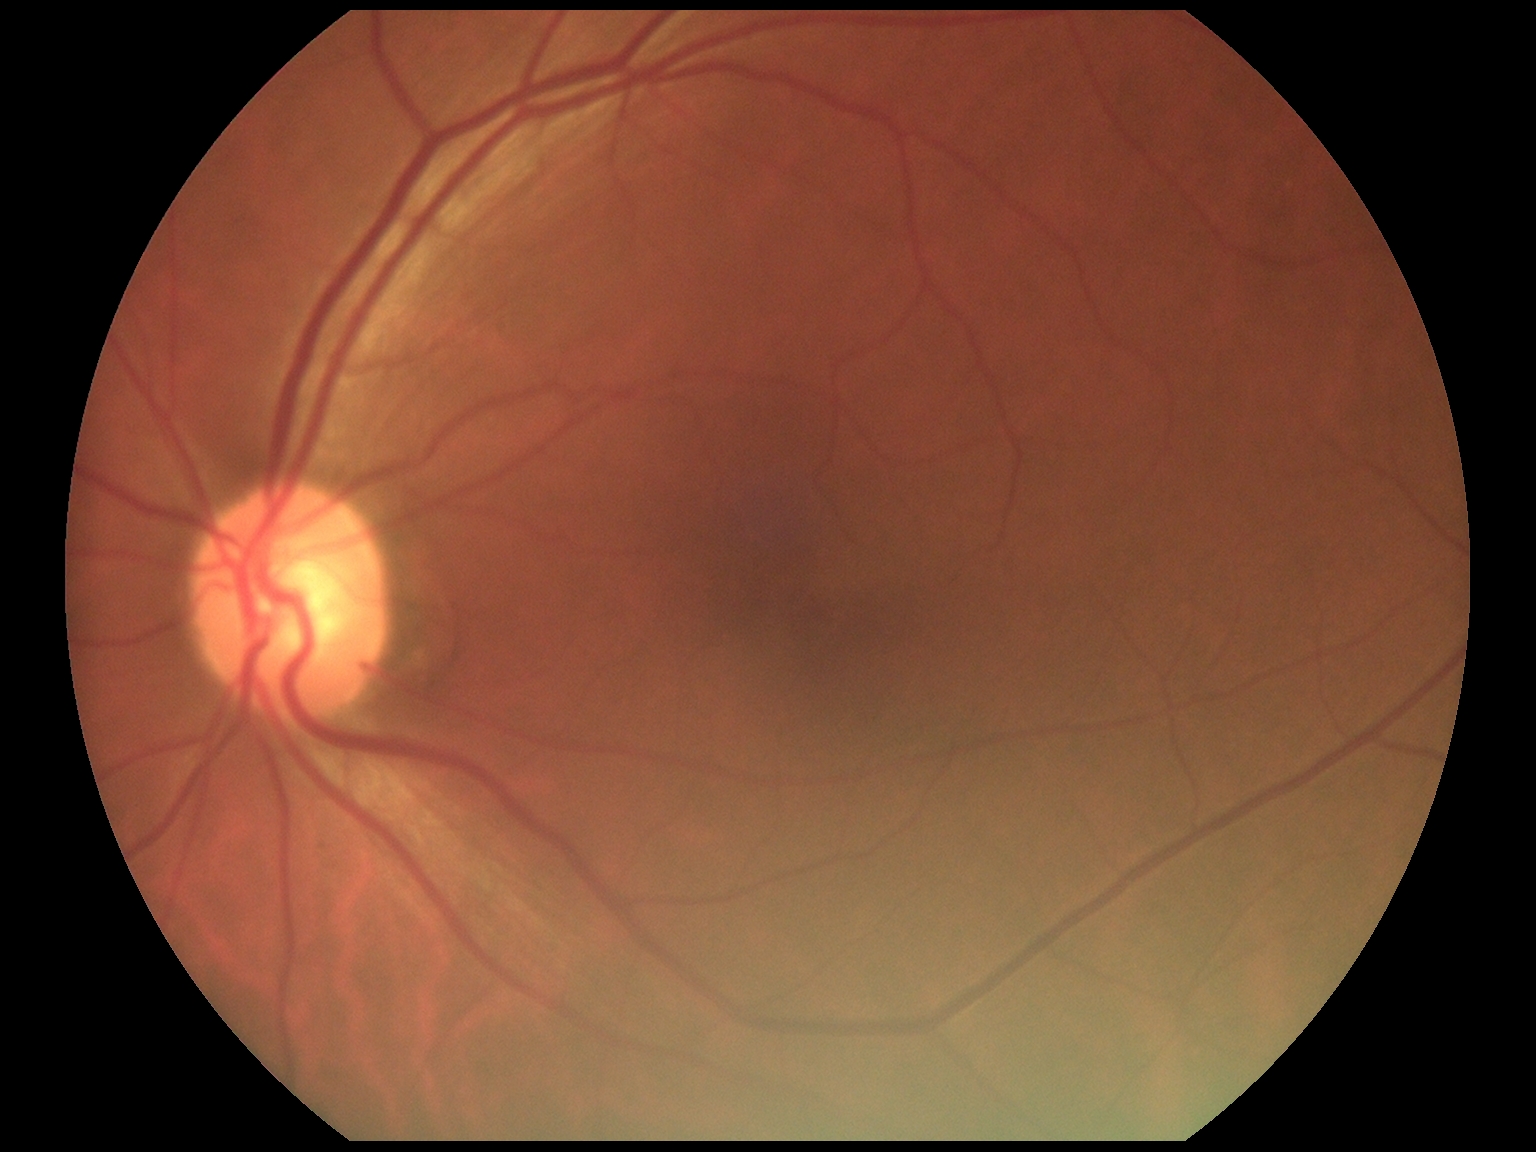

{"dr_grade": "grade 0 (no apparent retinopathy)"}